Retinal fundus photograph. 2352 x 1568 pixels. 45° FOV.
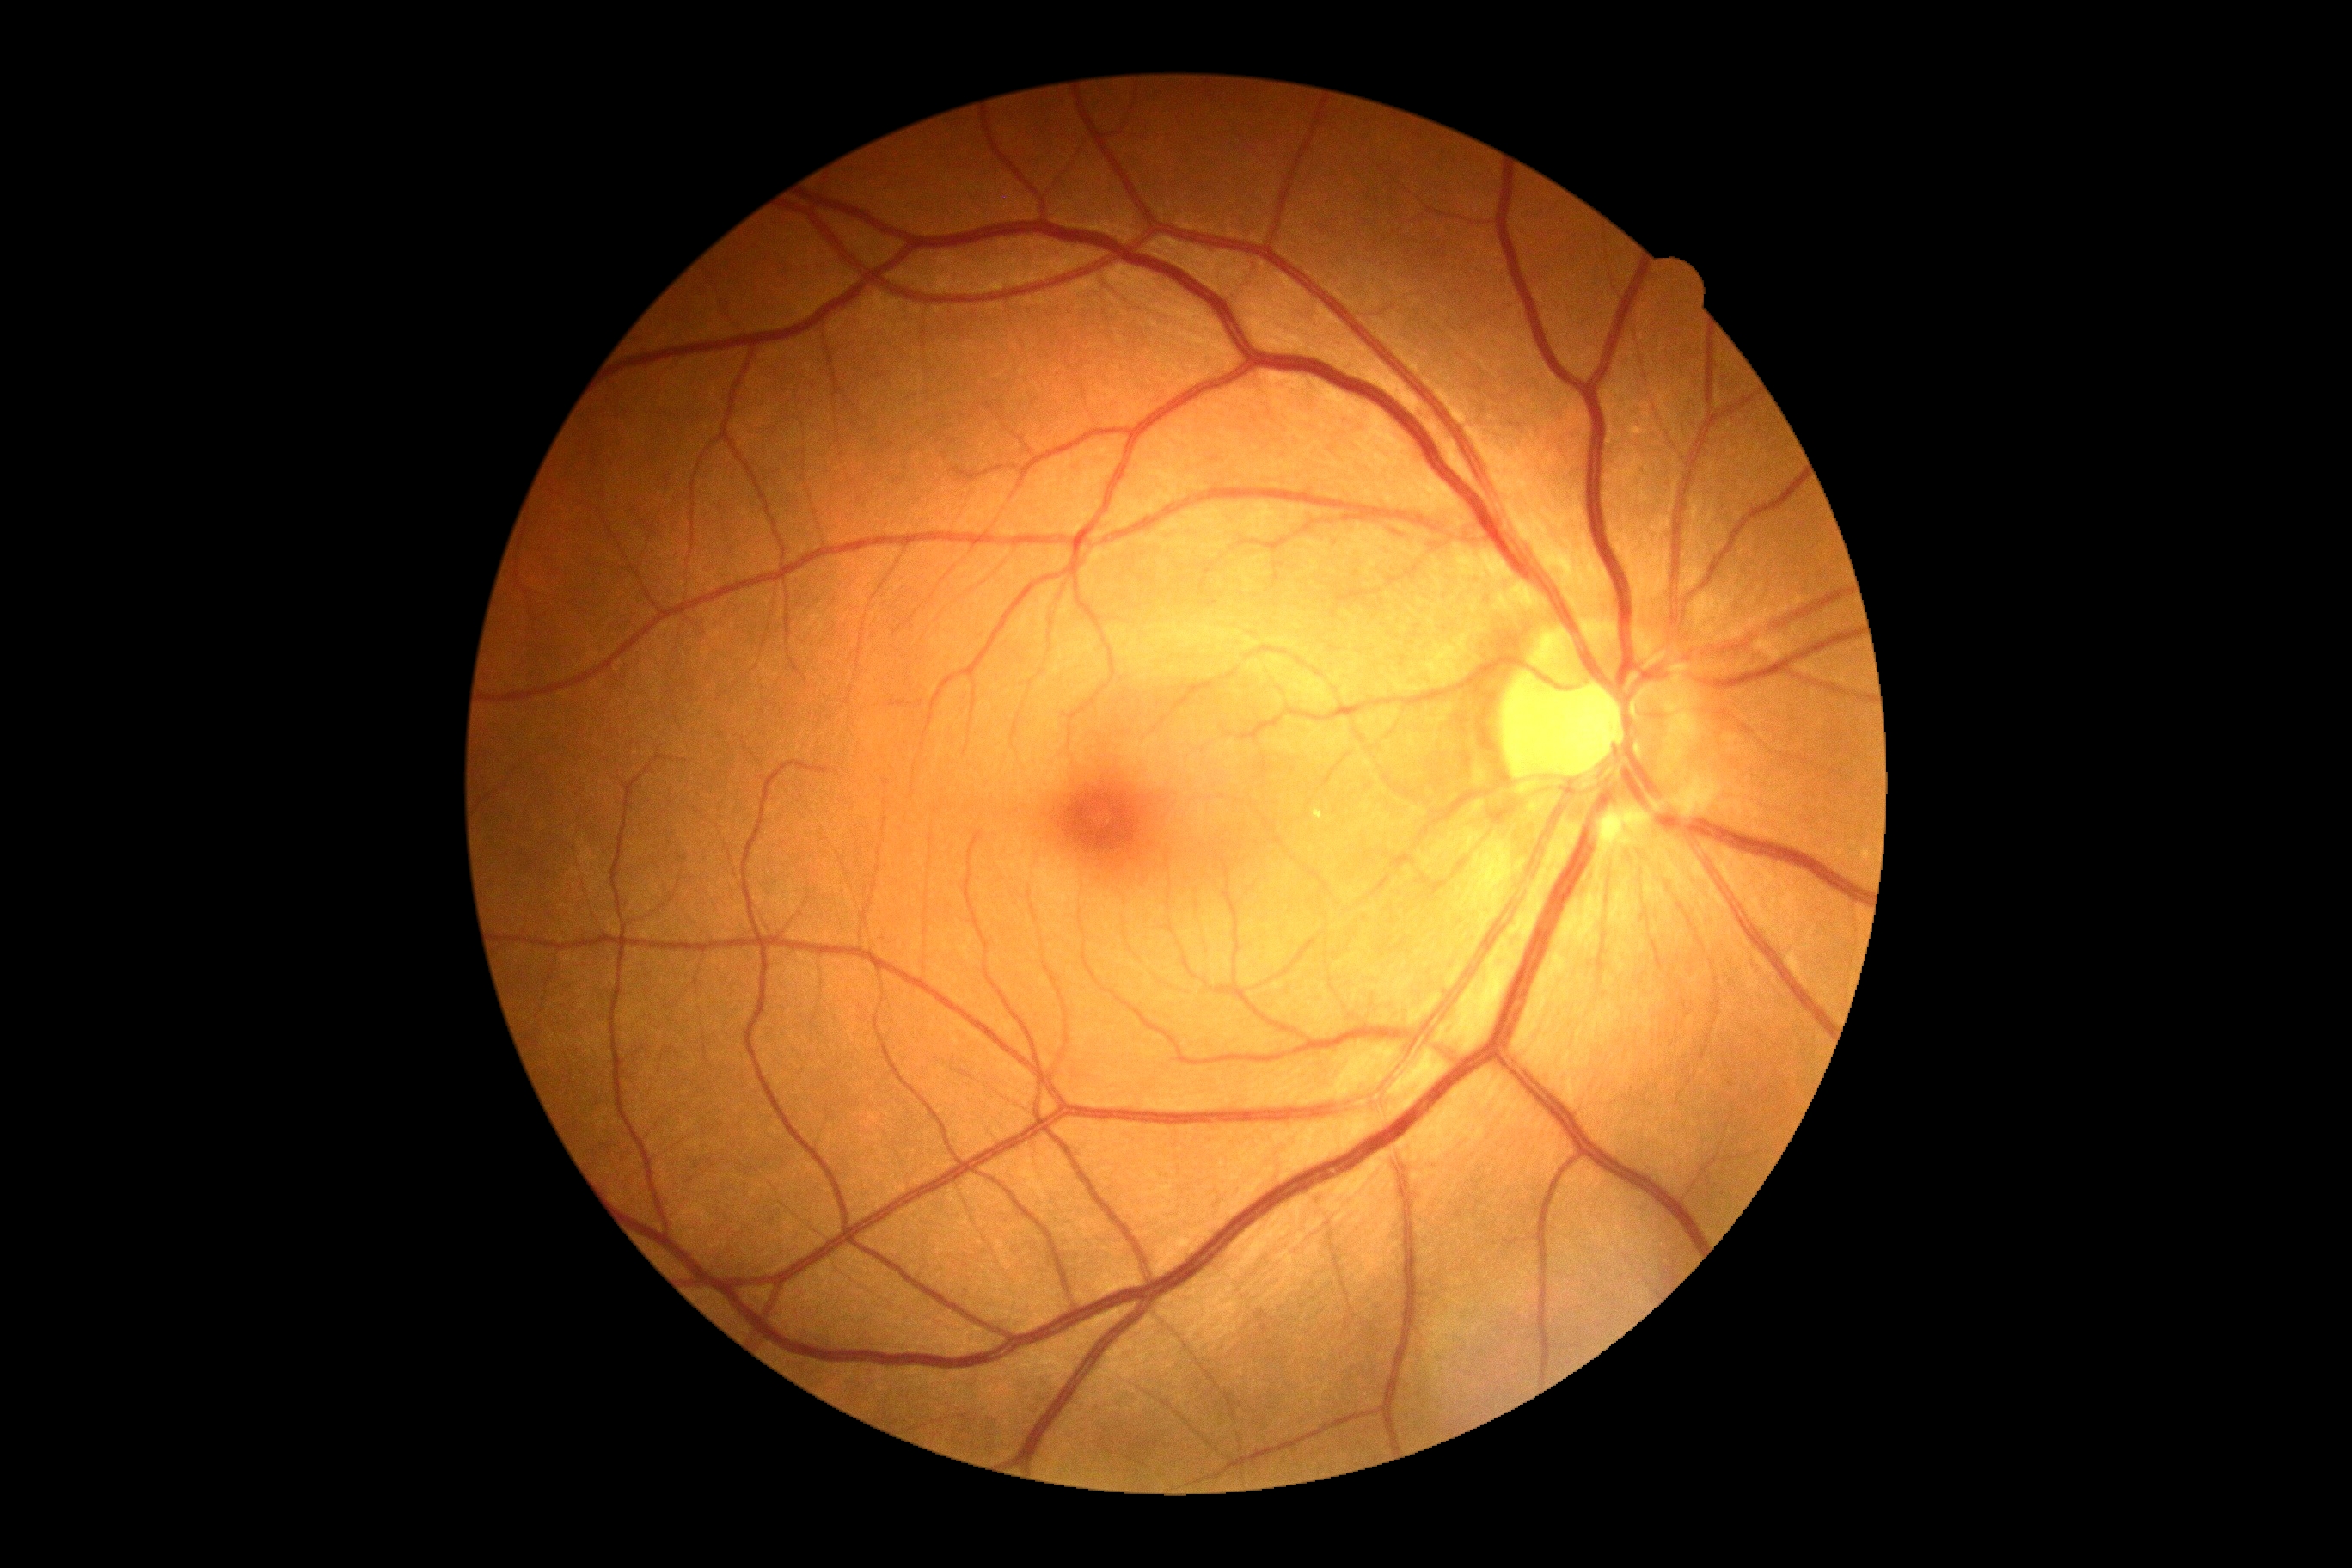 retinopathy=grade 0 (no apparent retinopathy); DR impression=no DR findings.